Image size 2212x1659, 45° field of view, color fundus photograph: 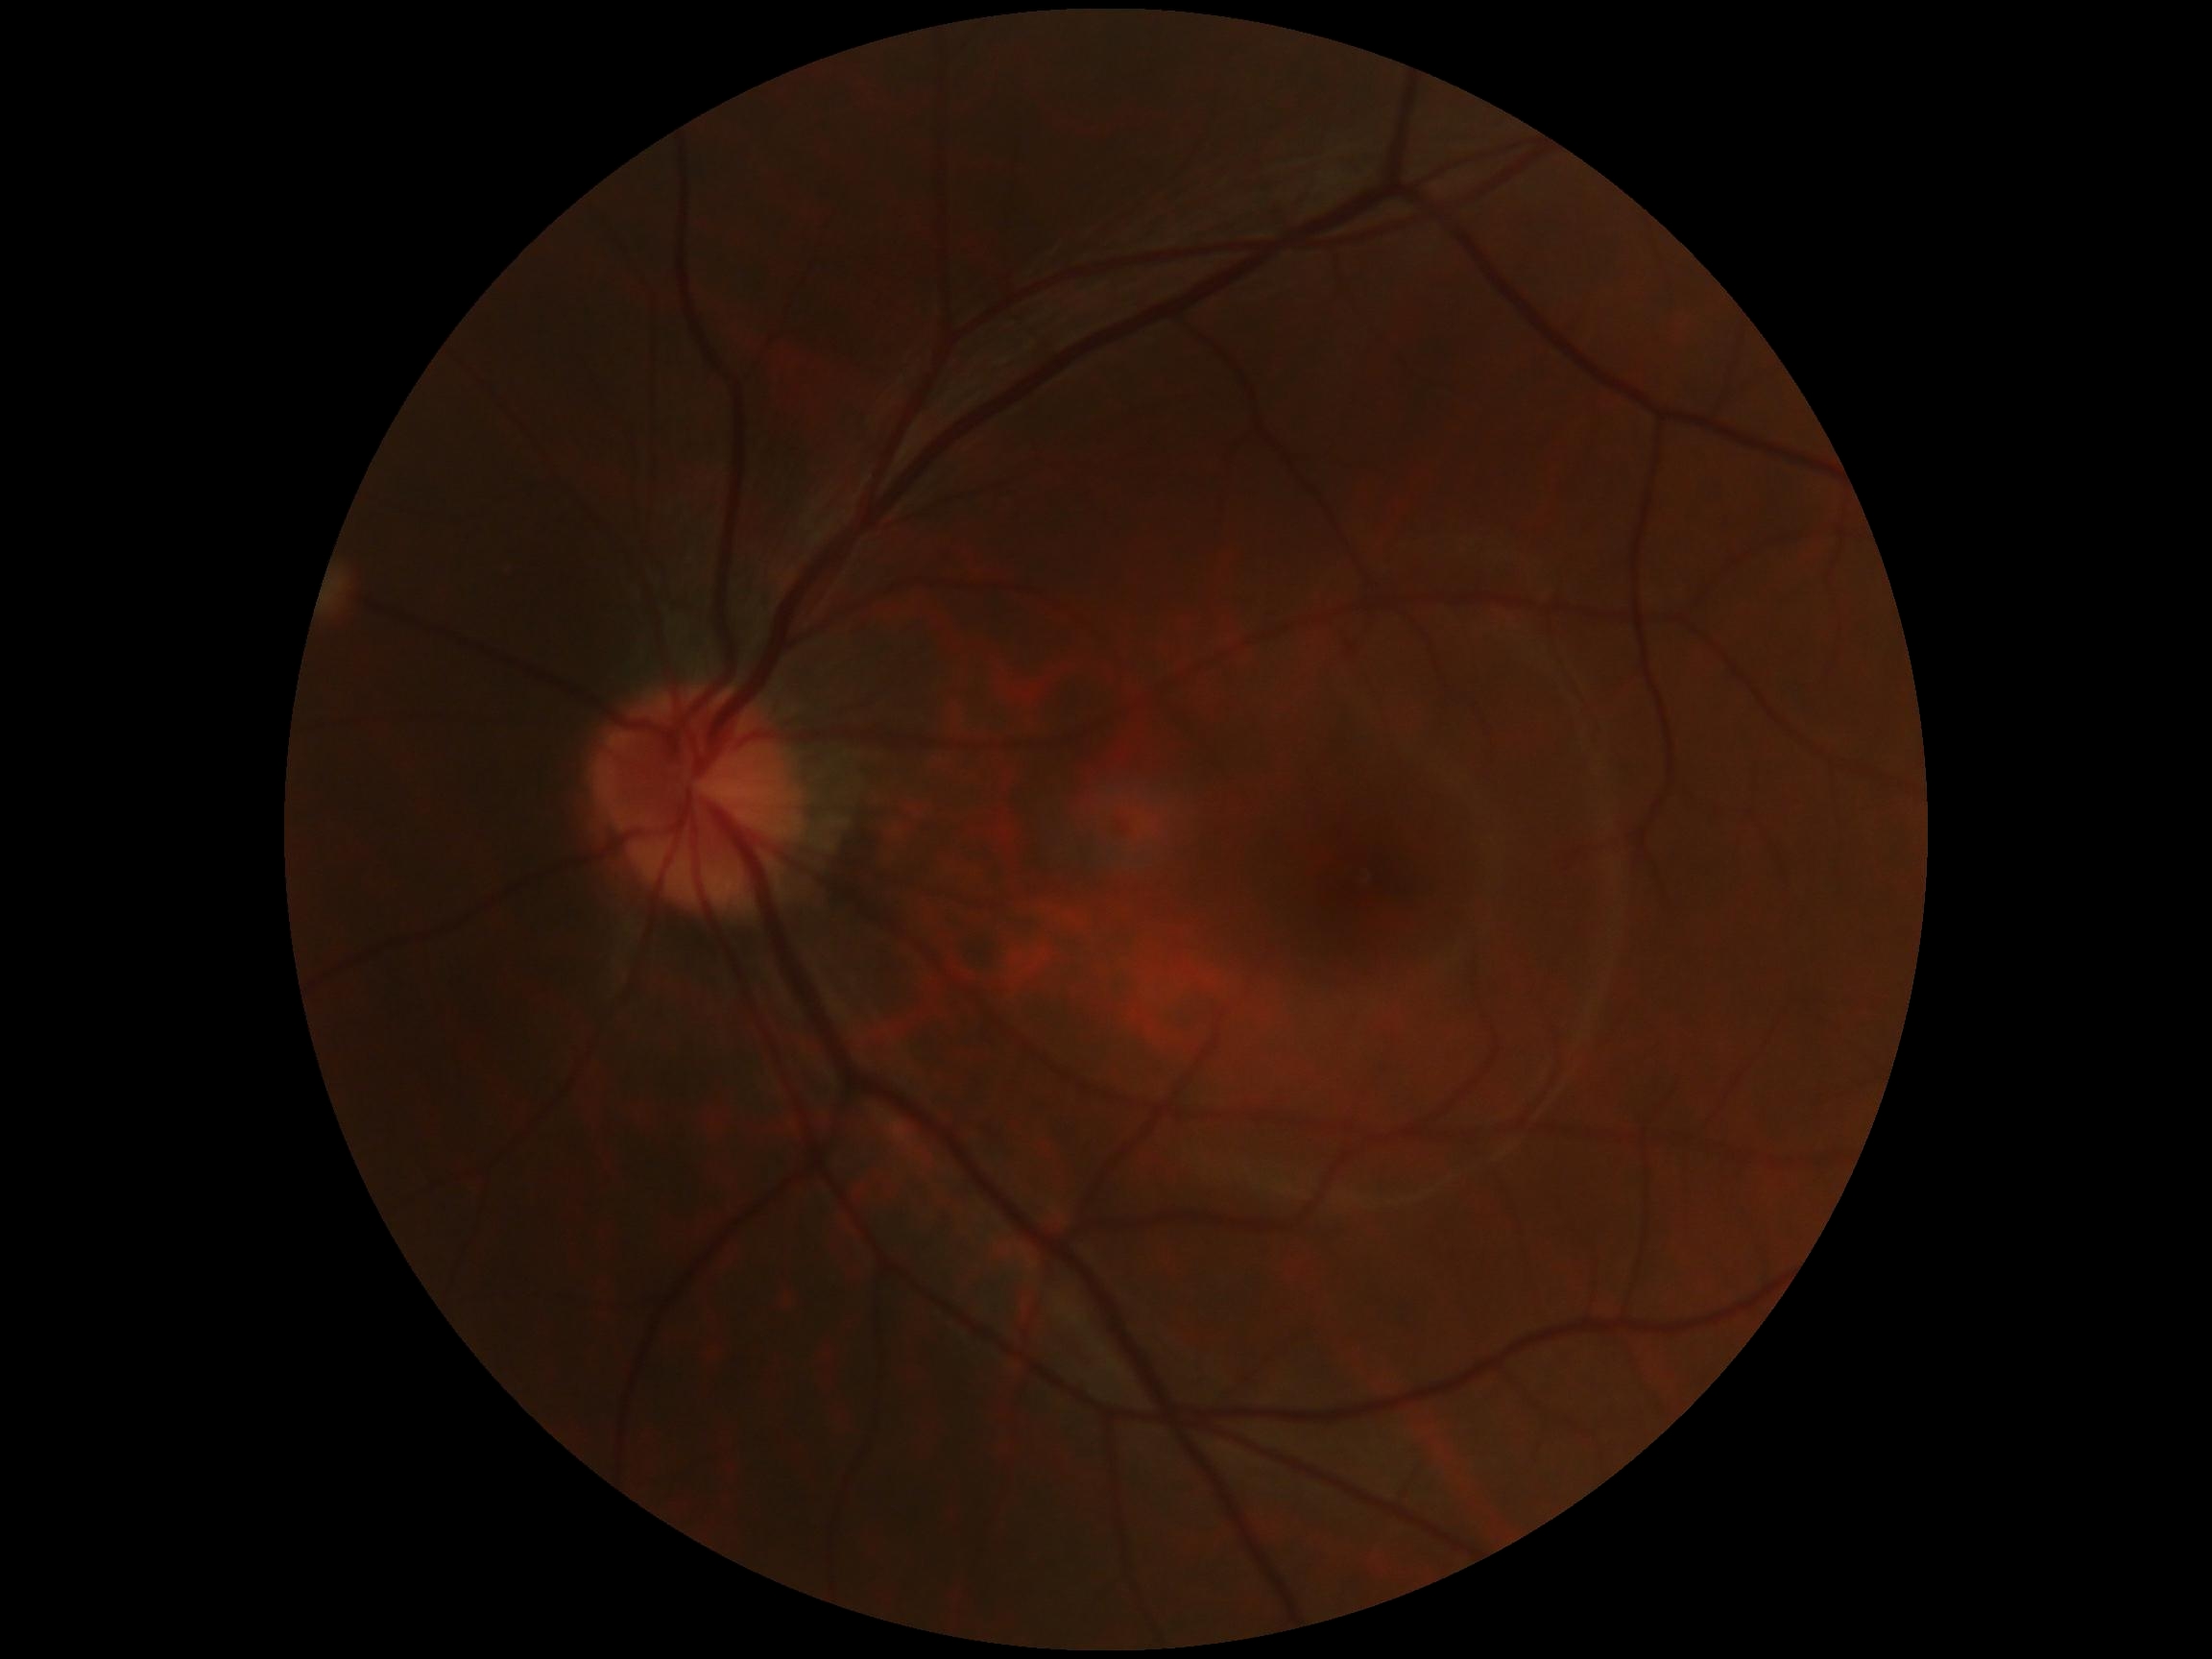

DR: no apparent retinopathy (grade 0).
No diabetic retinal disease findings.